Gender: M; autorefraction: -2 -0.5 x 100; color fundus photograph; age 65; axial length 26.68 mm; camera: Topcon TRC-NW400; 30° FOV; intraocular pressure (IOP) (pneumatic tonometry): 19 mmHg; image size 2212x1661; pachymetry: 550 µm — 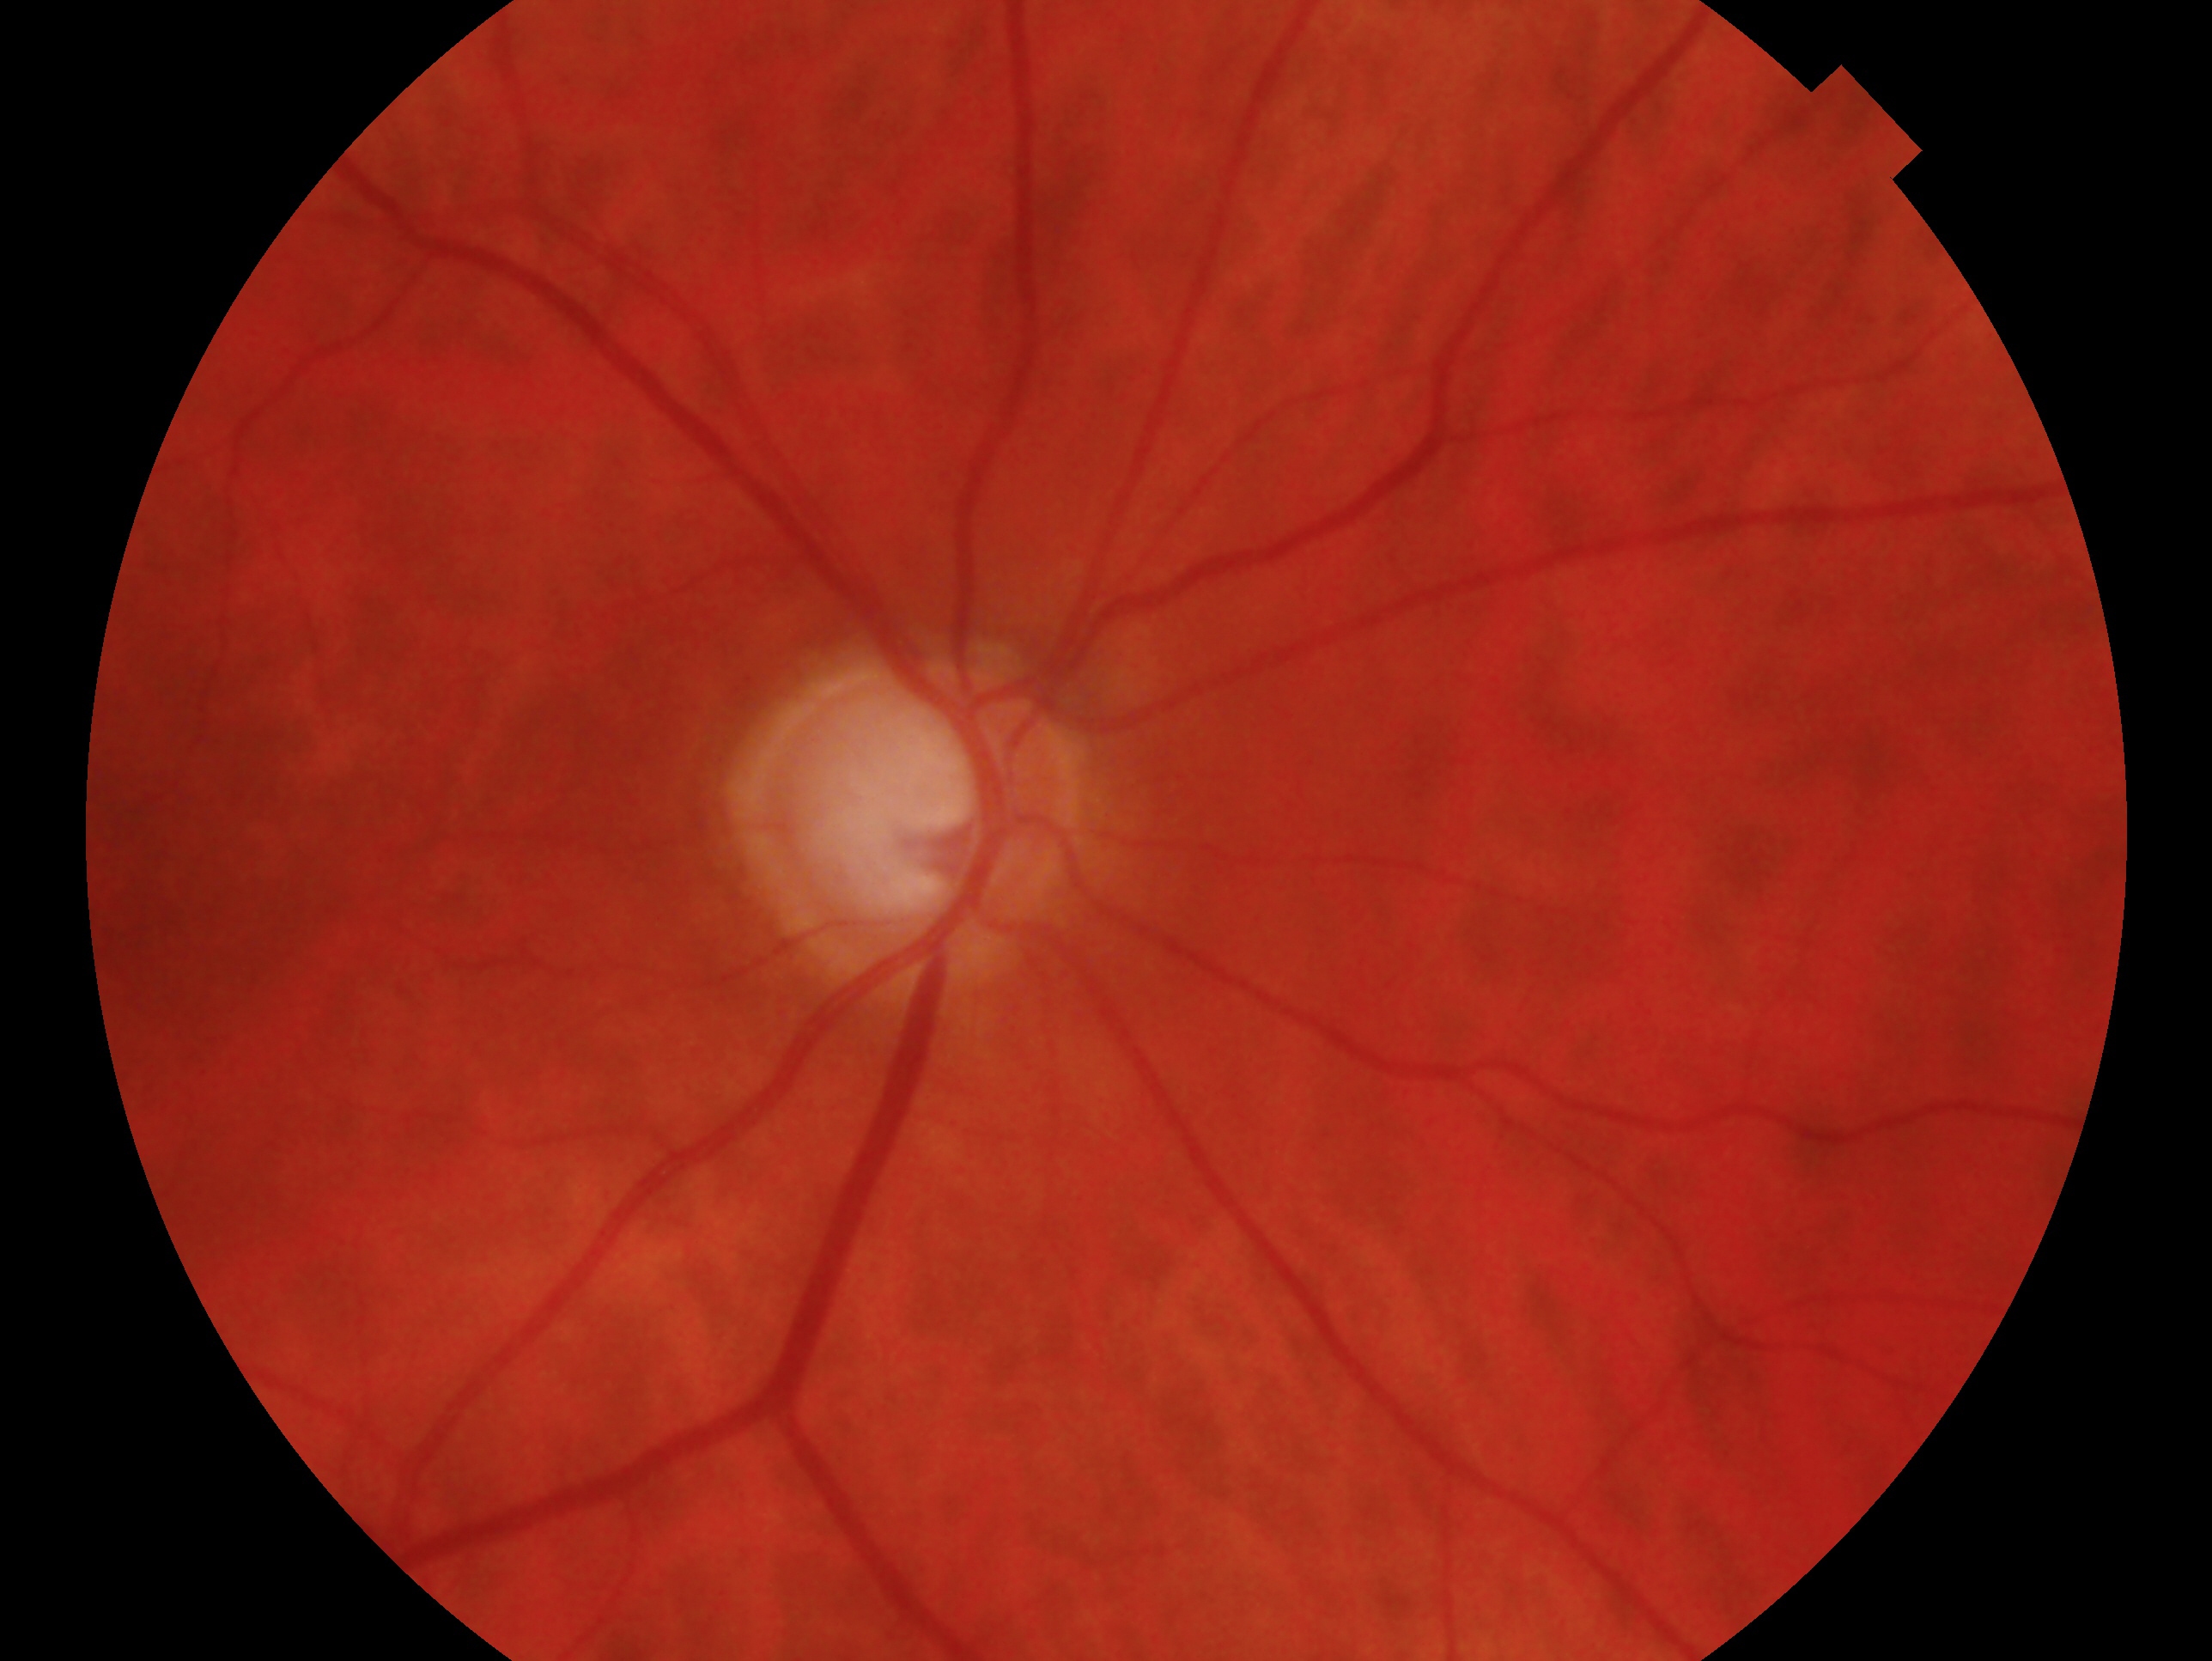

Eye: oculus dexter.
Clinical classification — consistent with glaucoma.